Fundus photo — 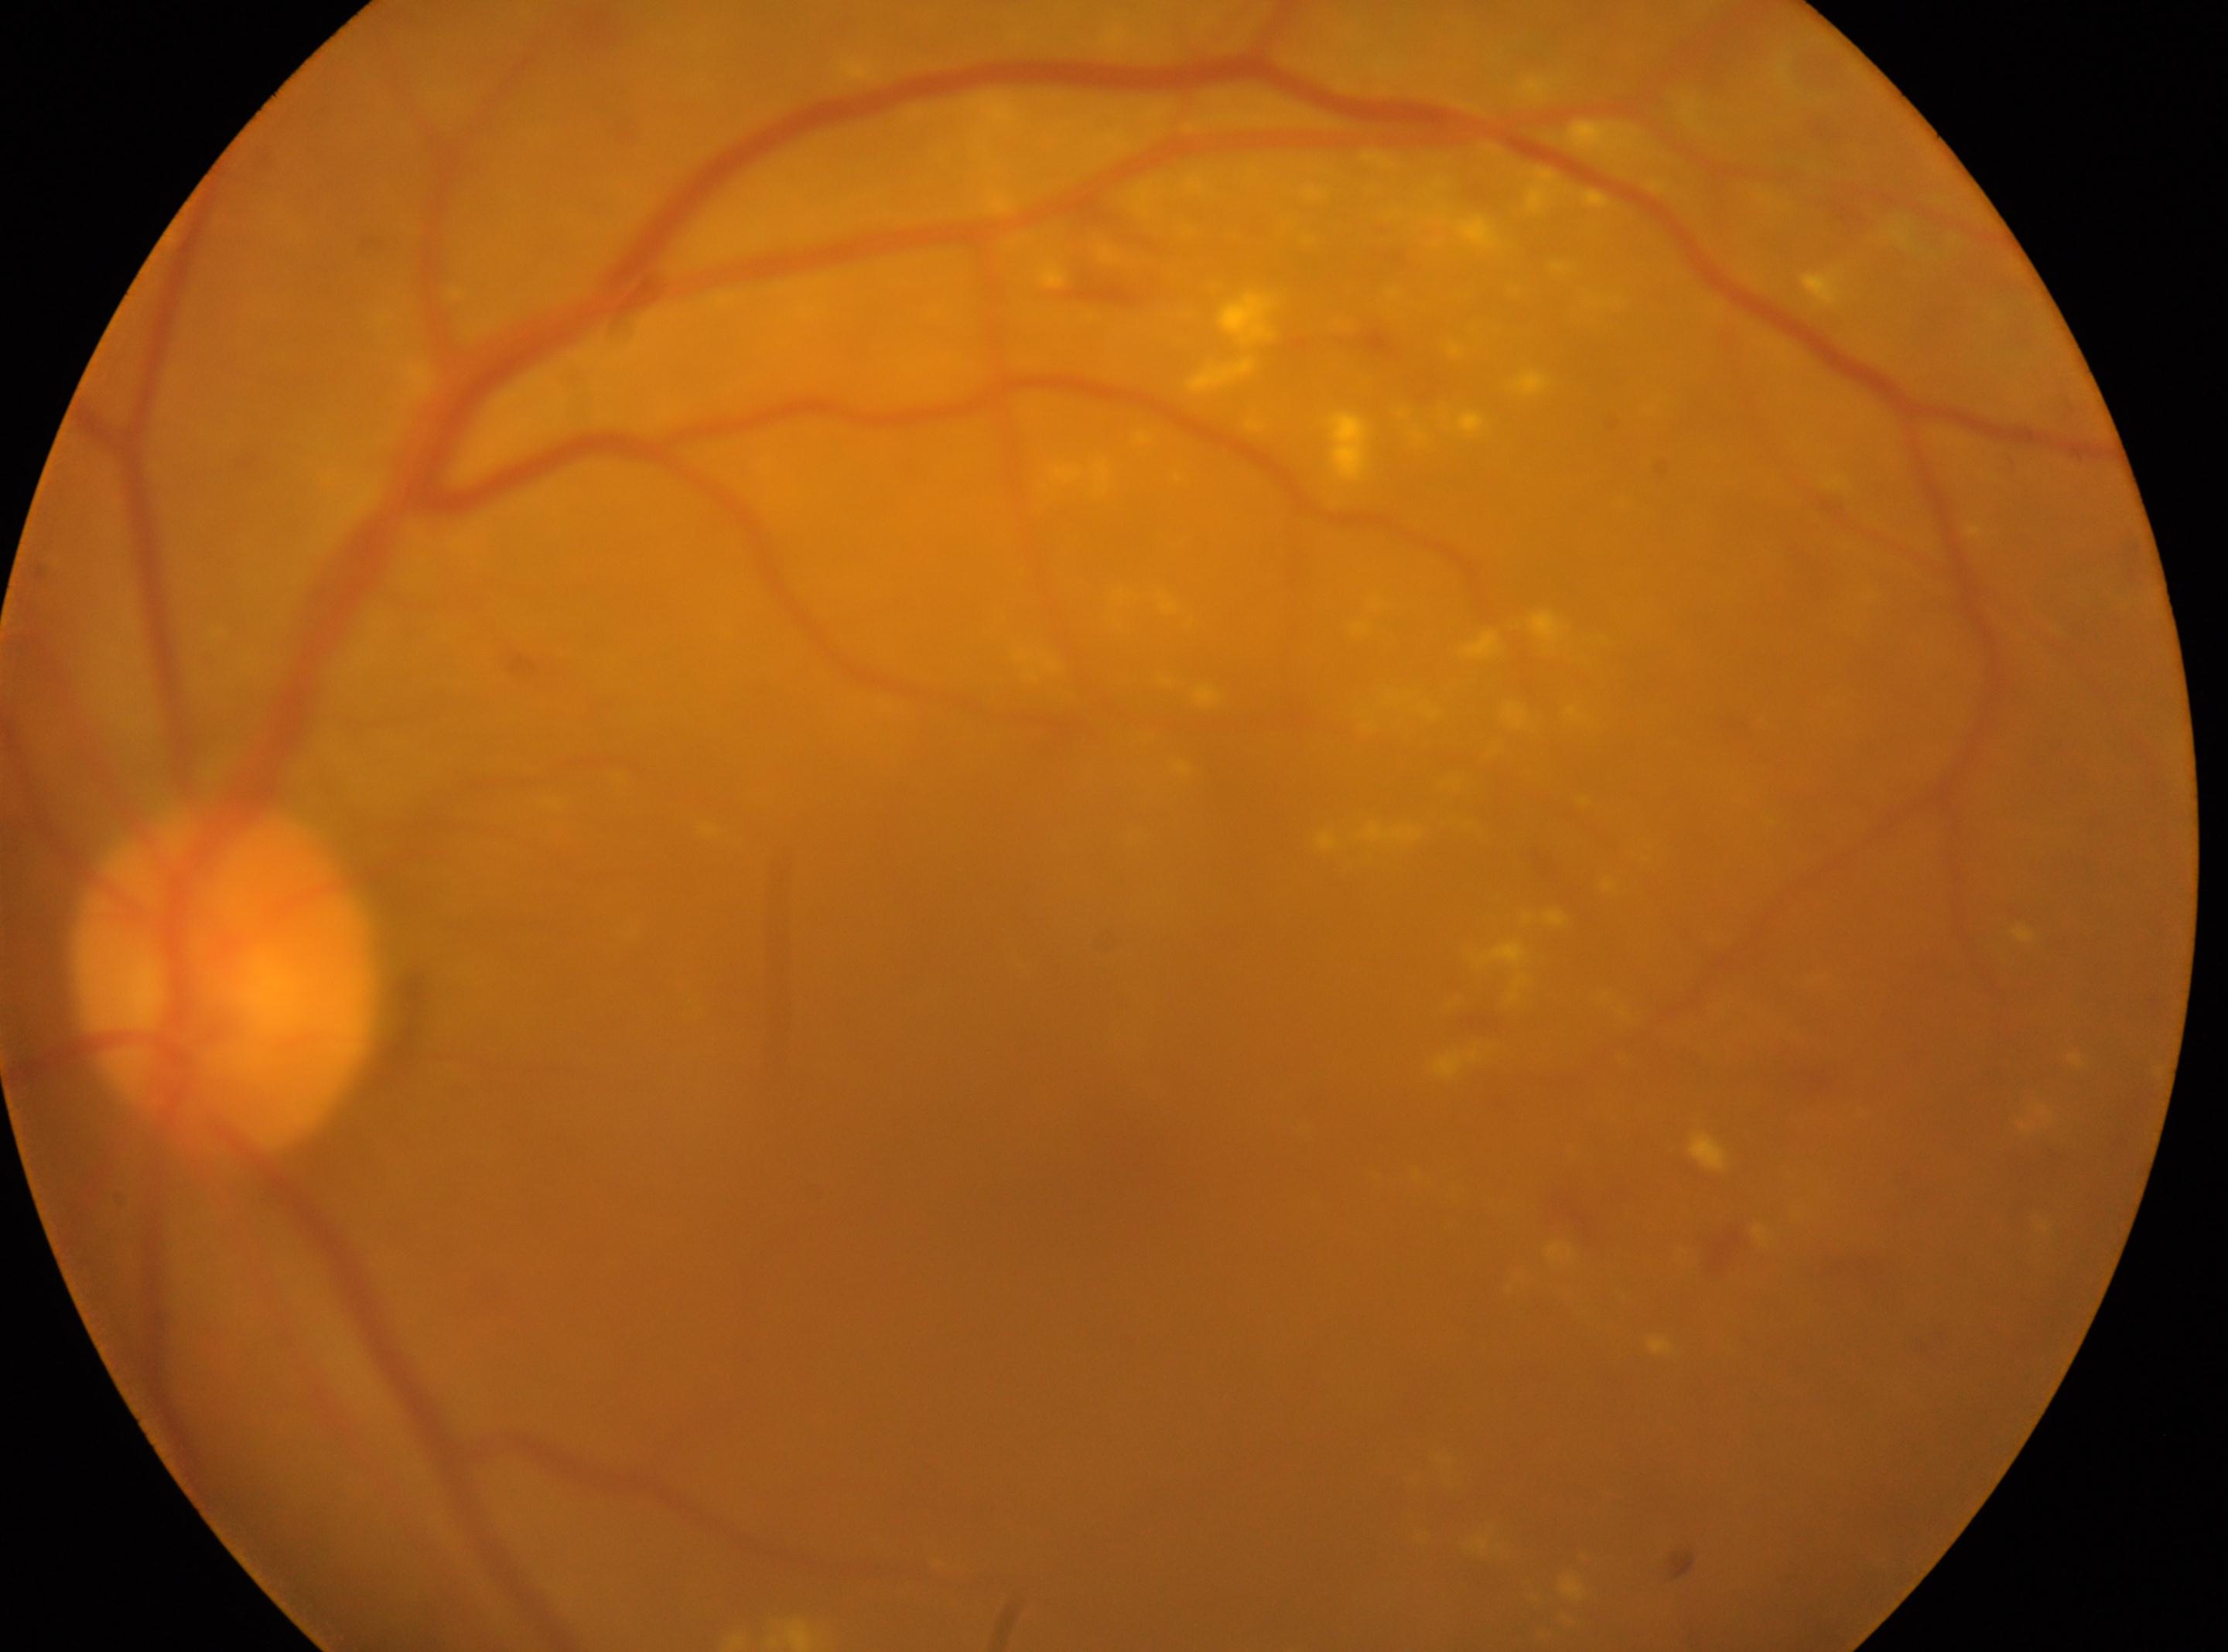

| feature | annotation |
|---|---|
| eye | OS |
| macular center | [1103, 1171] |
| DR | 2 — more than just microaneurysms but less than severe NPDR |
| the optic disc | [226, 978] |